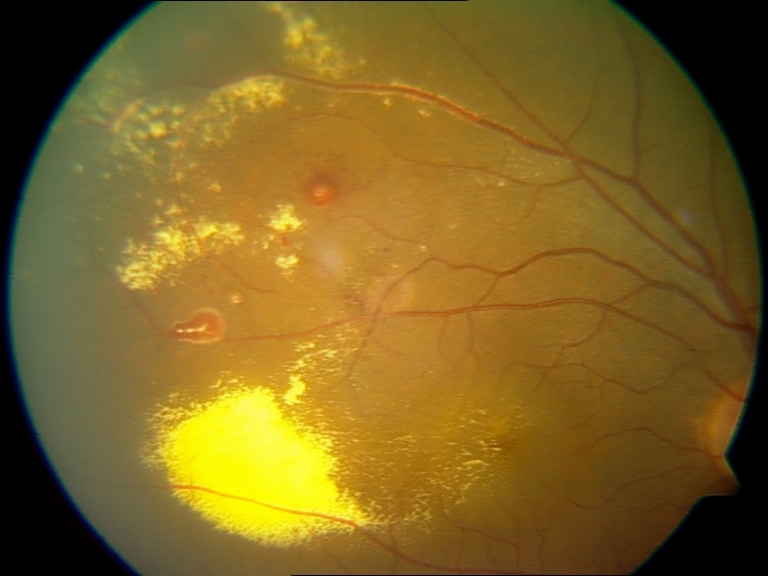 There is evidence of massive hard exudates.